Without pupil dilation. Camera: NIDEK AFC-230. Image size 848x848:
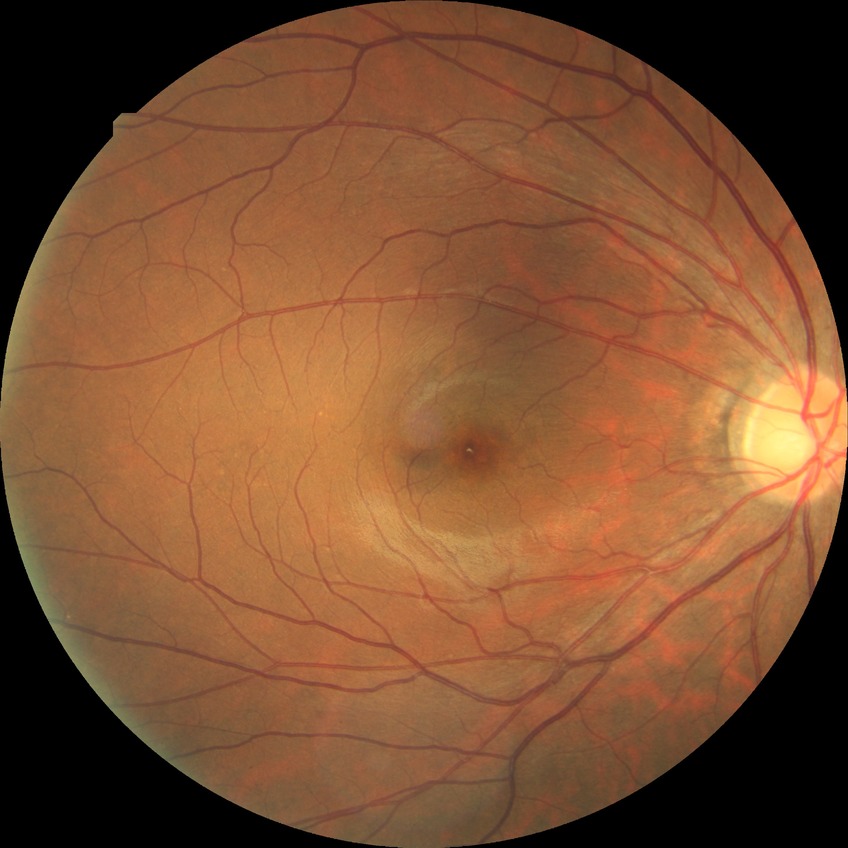

Retinopathy stage: no diabetic retinopathy.